RetCam wide-field infant fundus image — 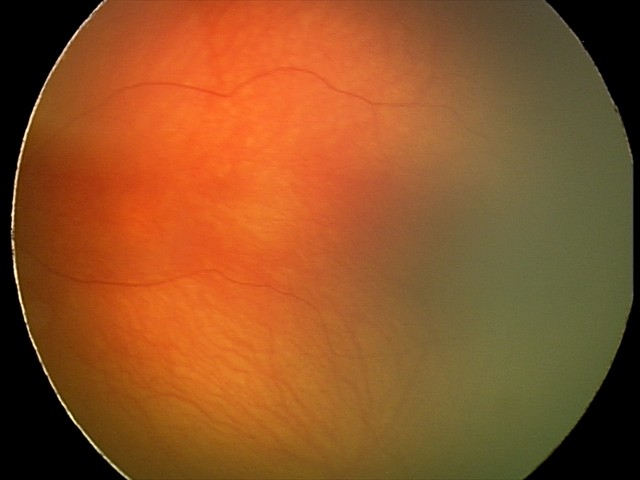 Q: What is the screening diagnosis?
A: physiological finding